Diabetic retinopathy graded by the modified Davis classification
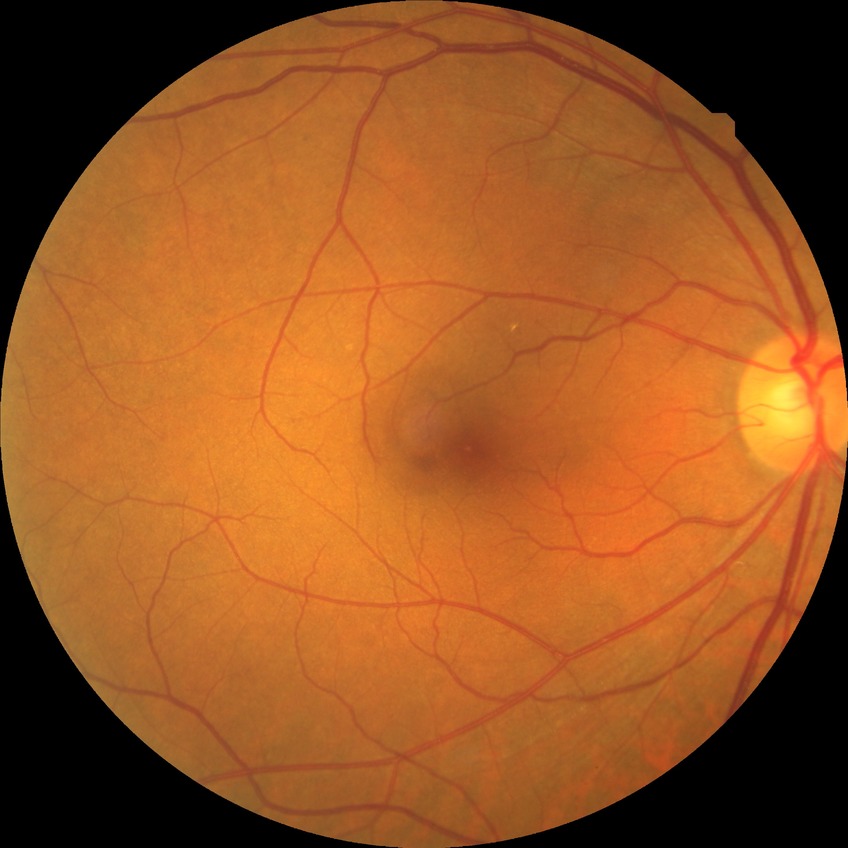

Annotations:
* diabetic retinopathy (DR): NDR (no diabetic retinopathy)